Wide-field fundus photograph of an infant.
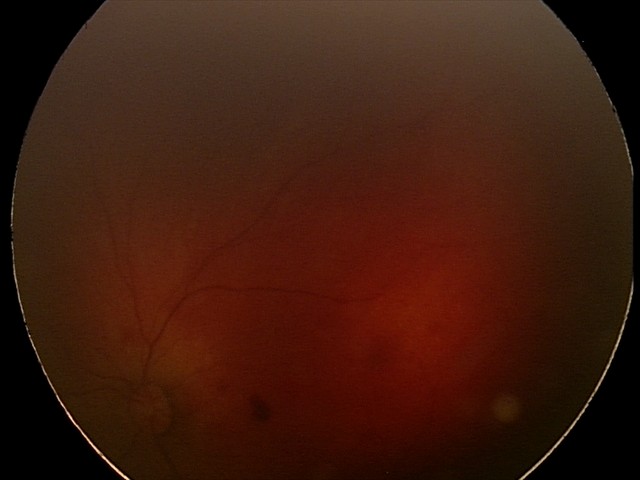
Examination diagnosed as retinal hemorrhages.